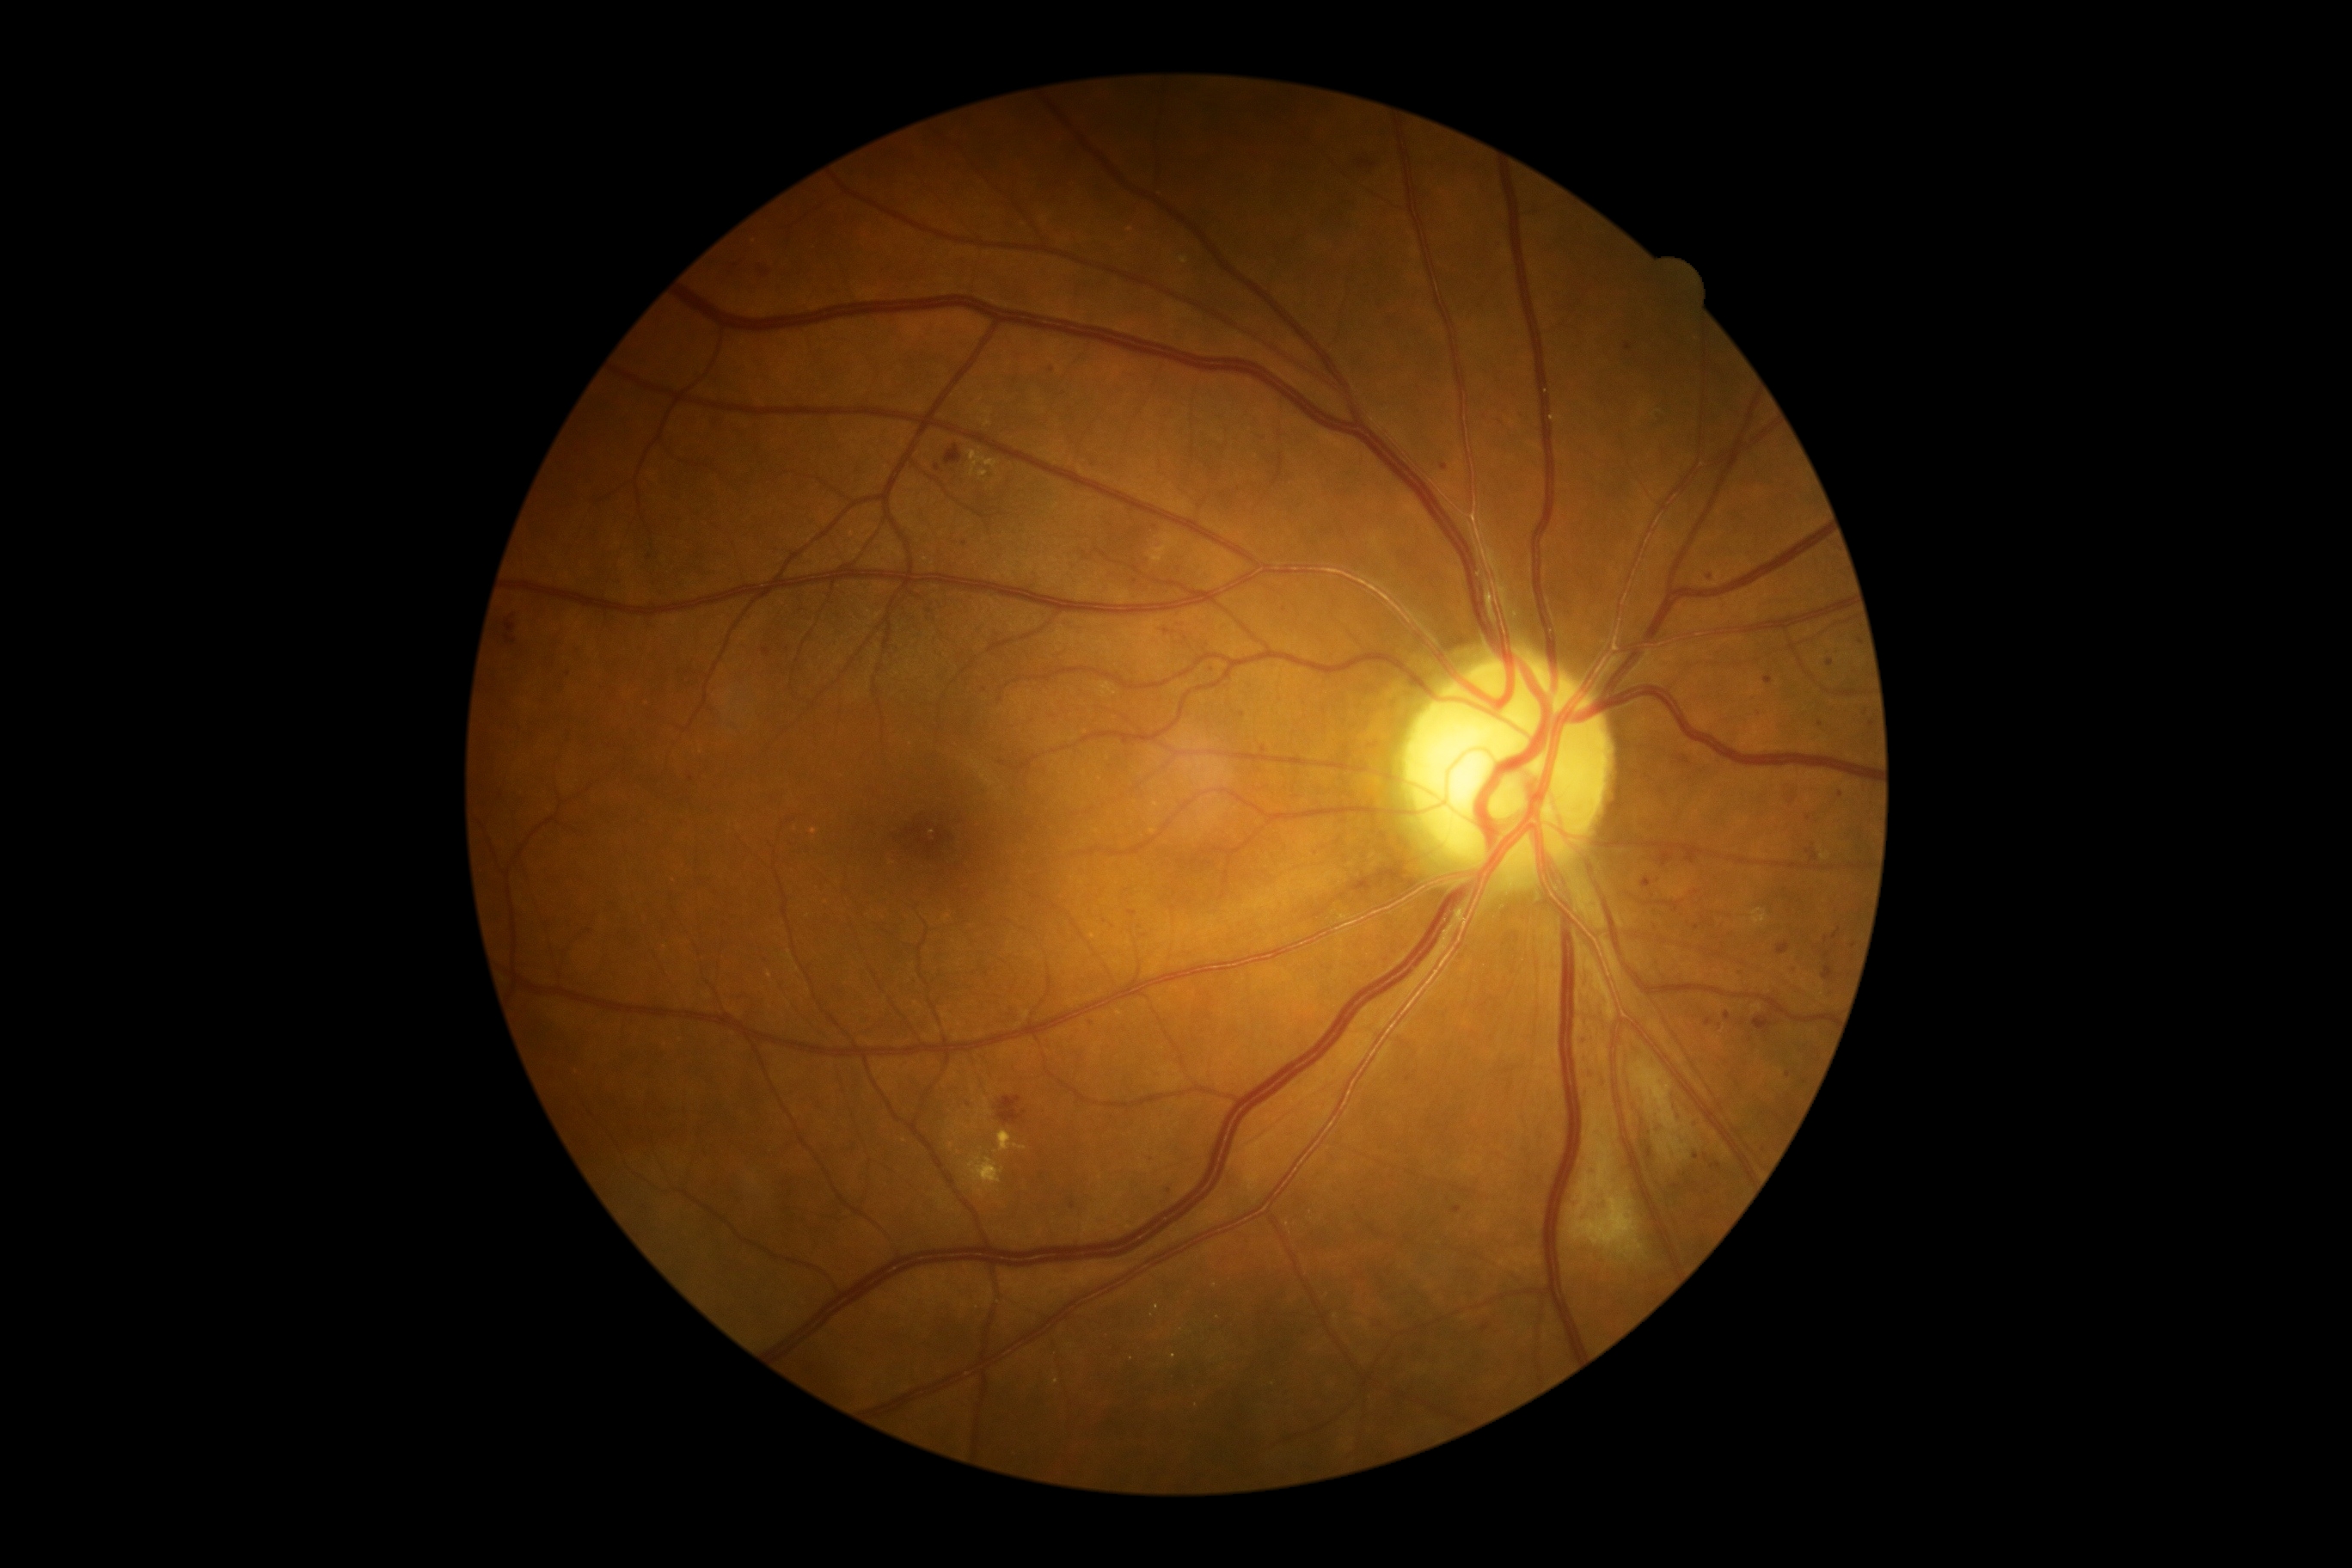 {"partial": true, "dr_grade": 2, "lesions": {"ma": [[1686, 854, 1698, 864], [1591, 1168, 1596, 1177], [1646, 1148, 1653, 1160], [1822, 965, 1835, 981], [1763, 677, 1773, 685], [1124, 740, 1137, 745], [1789, 799, 1798, 805]], "ma_small_approx": [[1809, 818], [1444, 467], [568, 675], [1744, 972], [992, 509], [1135, 582], [964, 543], [1104, 924], [1723, 946], [1523, 417], [1685, 760]]}}